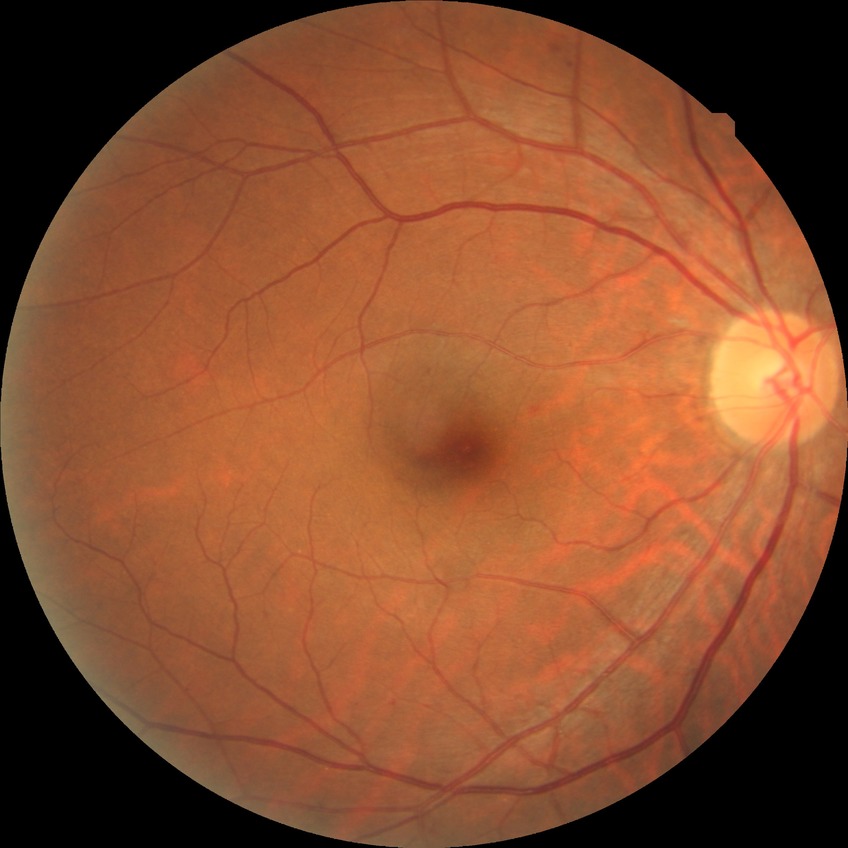 Diabetic retinopathy (DR) is SDR (simple diabetic retinopathy).